FOV: 50 degrees.
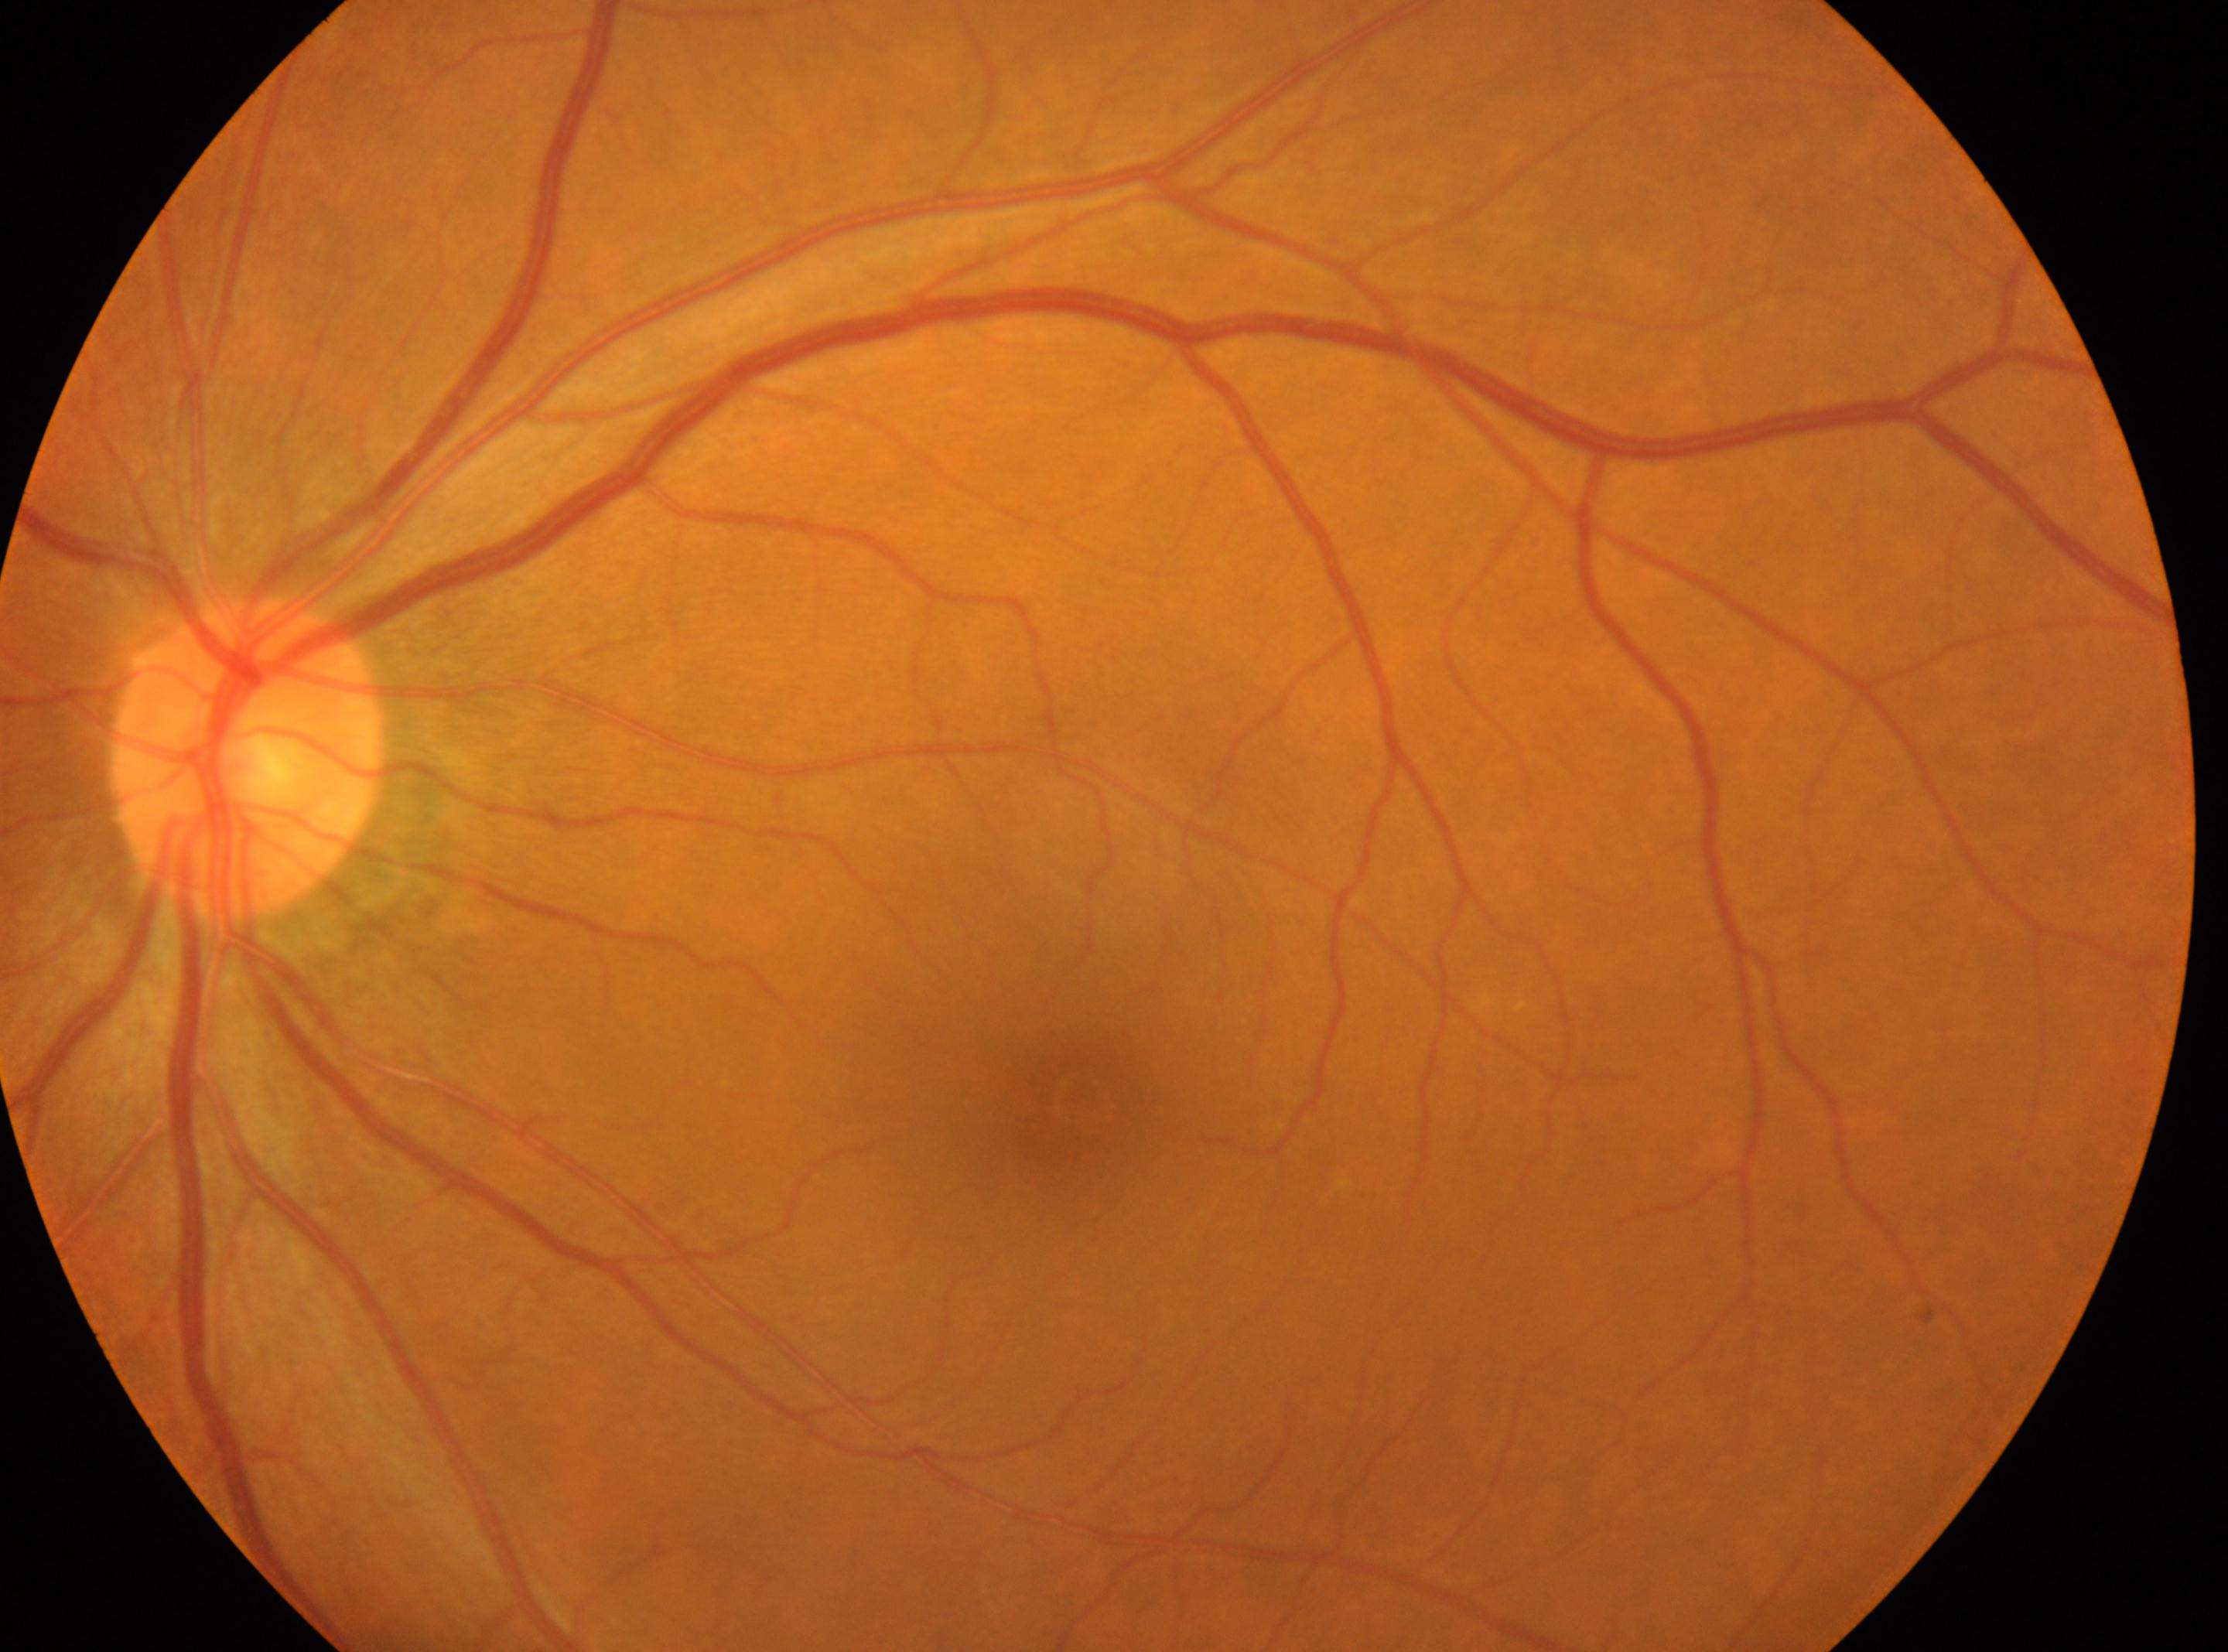

No diabetic retinal disease findings.
This is the oculus sinister.
The foveal center is at 1078px, 1091px.
Optic nerve head located at 246px, 758px.
Diabetic retinopathy (DR) is no apparent diabetic retinopathy (grade 0) — no visible signs of diabetic retinopathy.